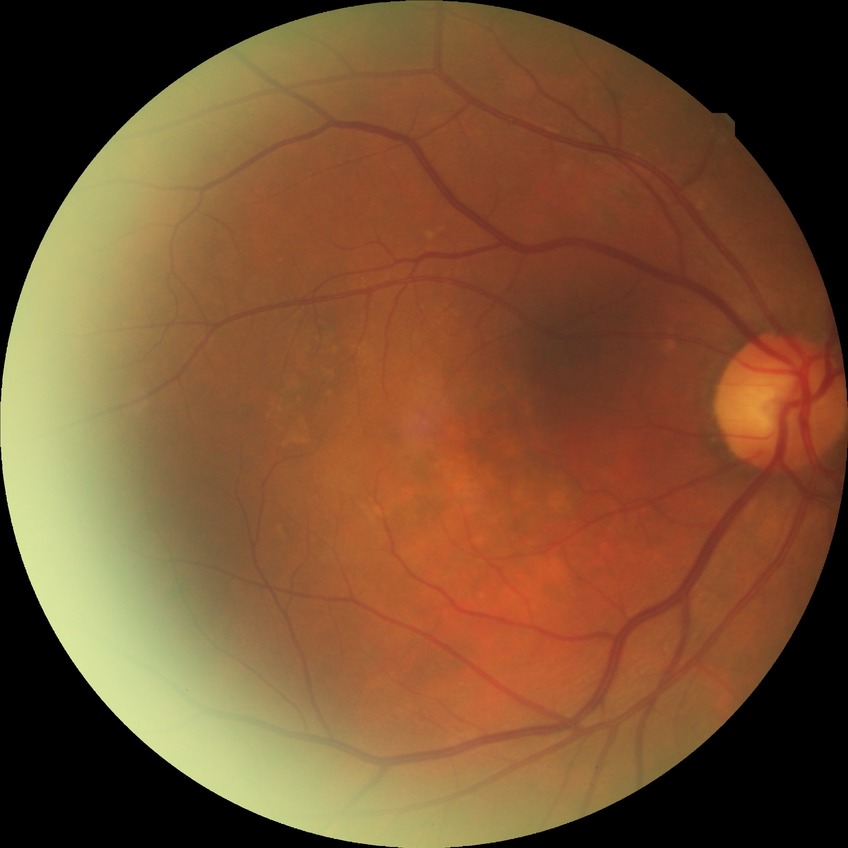

DR grade is NDR. No apparent diabetic retinopathy.